Davis DR grading, posterior pole color fundus photograph, nonmydriatic fundus photograph:
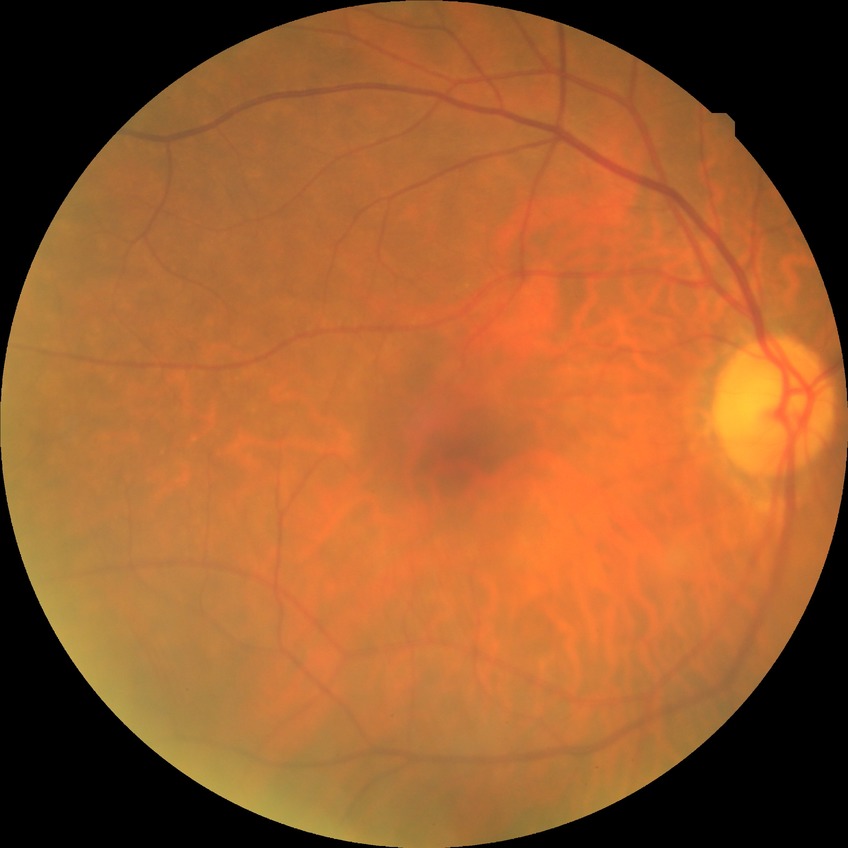
{
  "davis_grade": "no diabetic retinopathy (NDR)"
}